Davis DR grading · FOV: 45 degrees · nonmydriatic fundus photograph · image size 848x848: 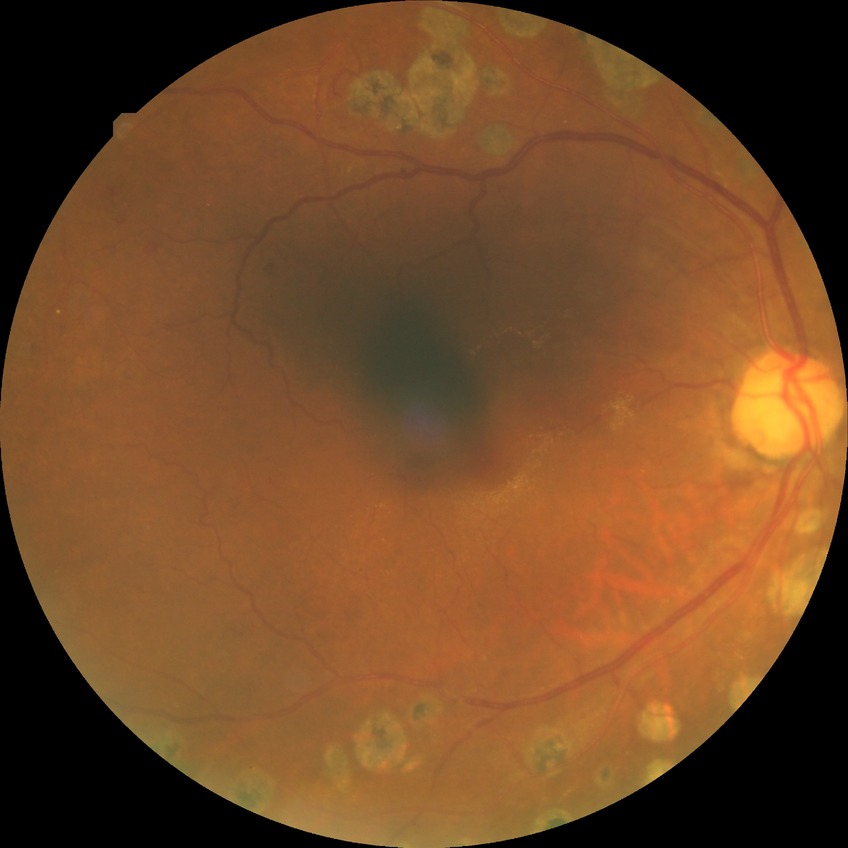 diabetic retinopathy (DR): PDR (proliferative diabetic retinopathy).